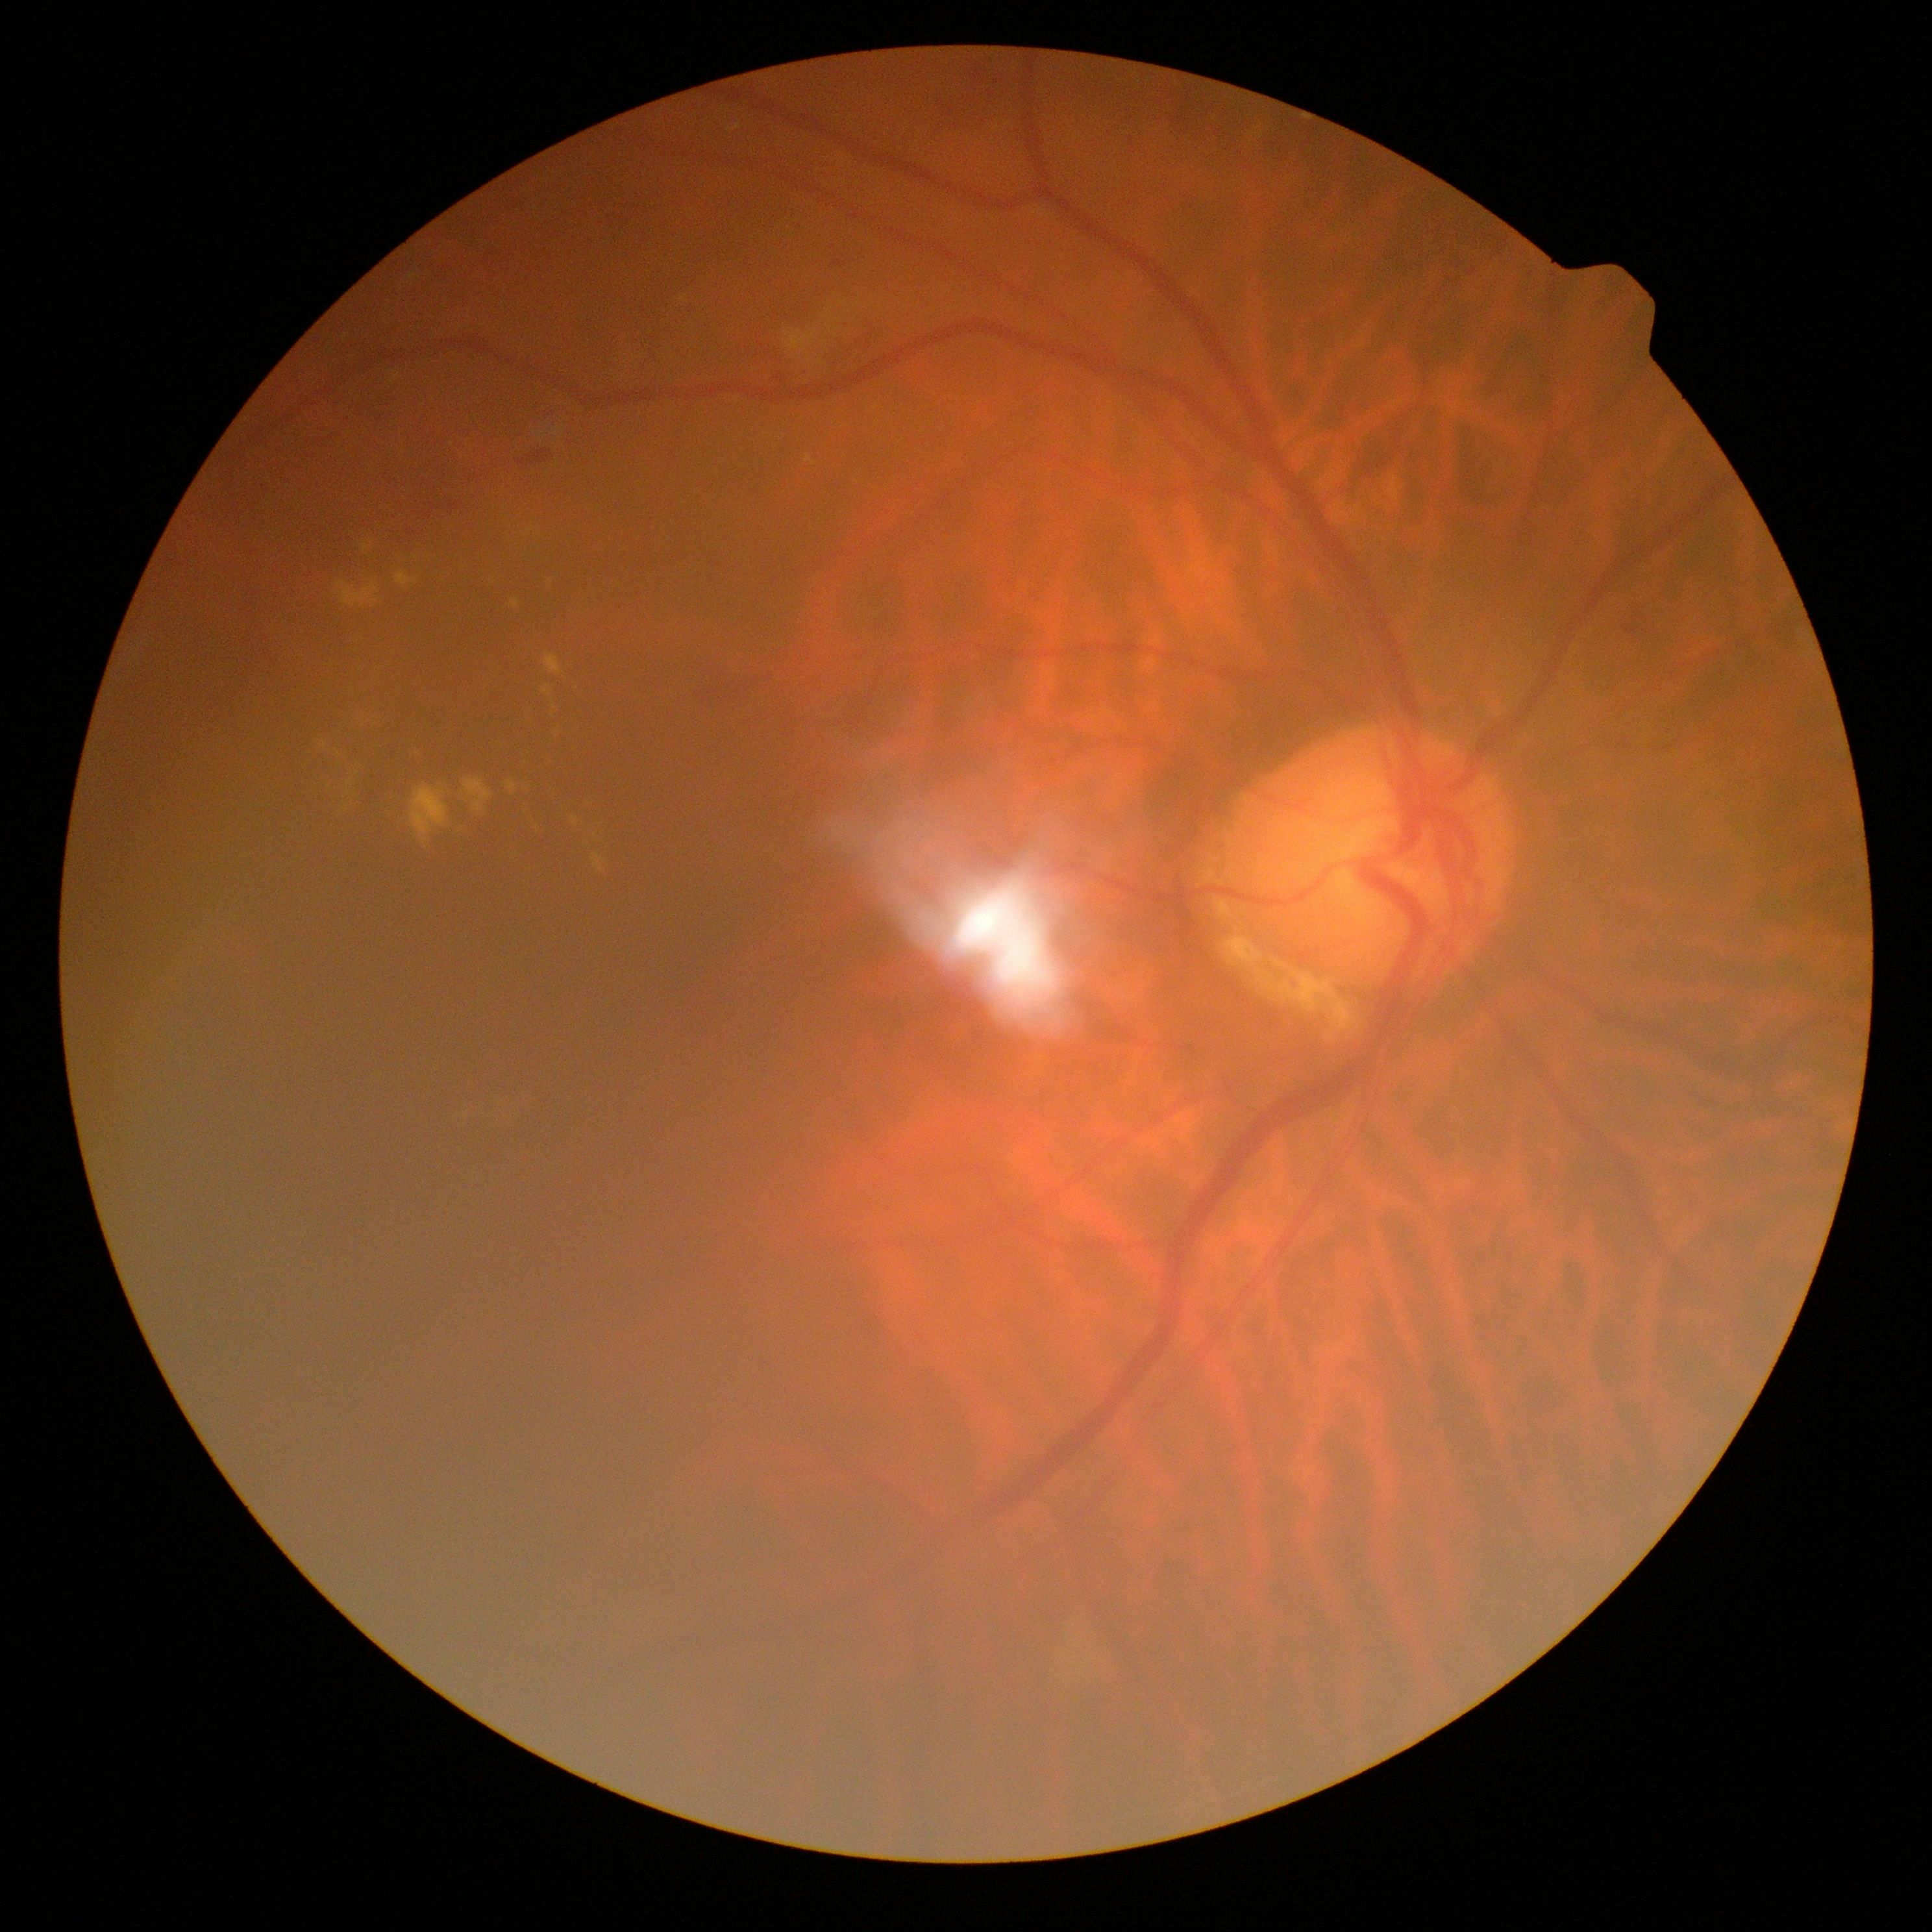 diabetic retinopathy (DR): grade 2 (moderate NPDR).